Retinal fundus photograph — 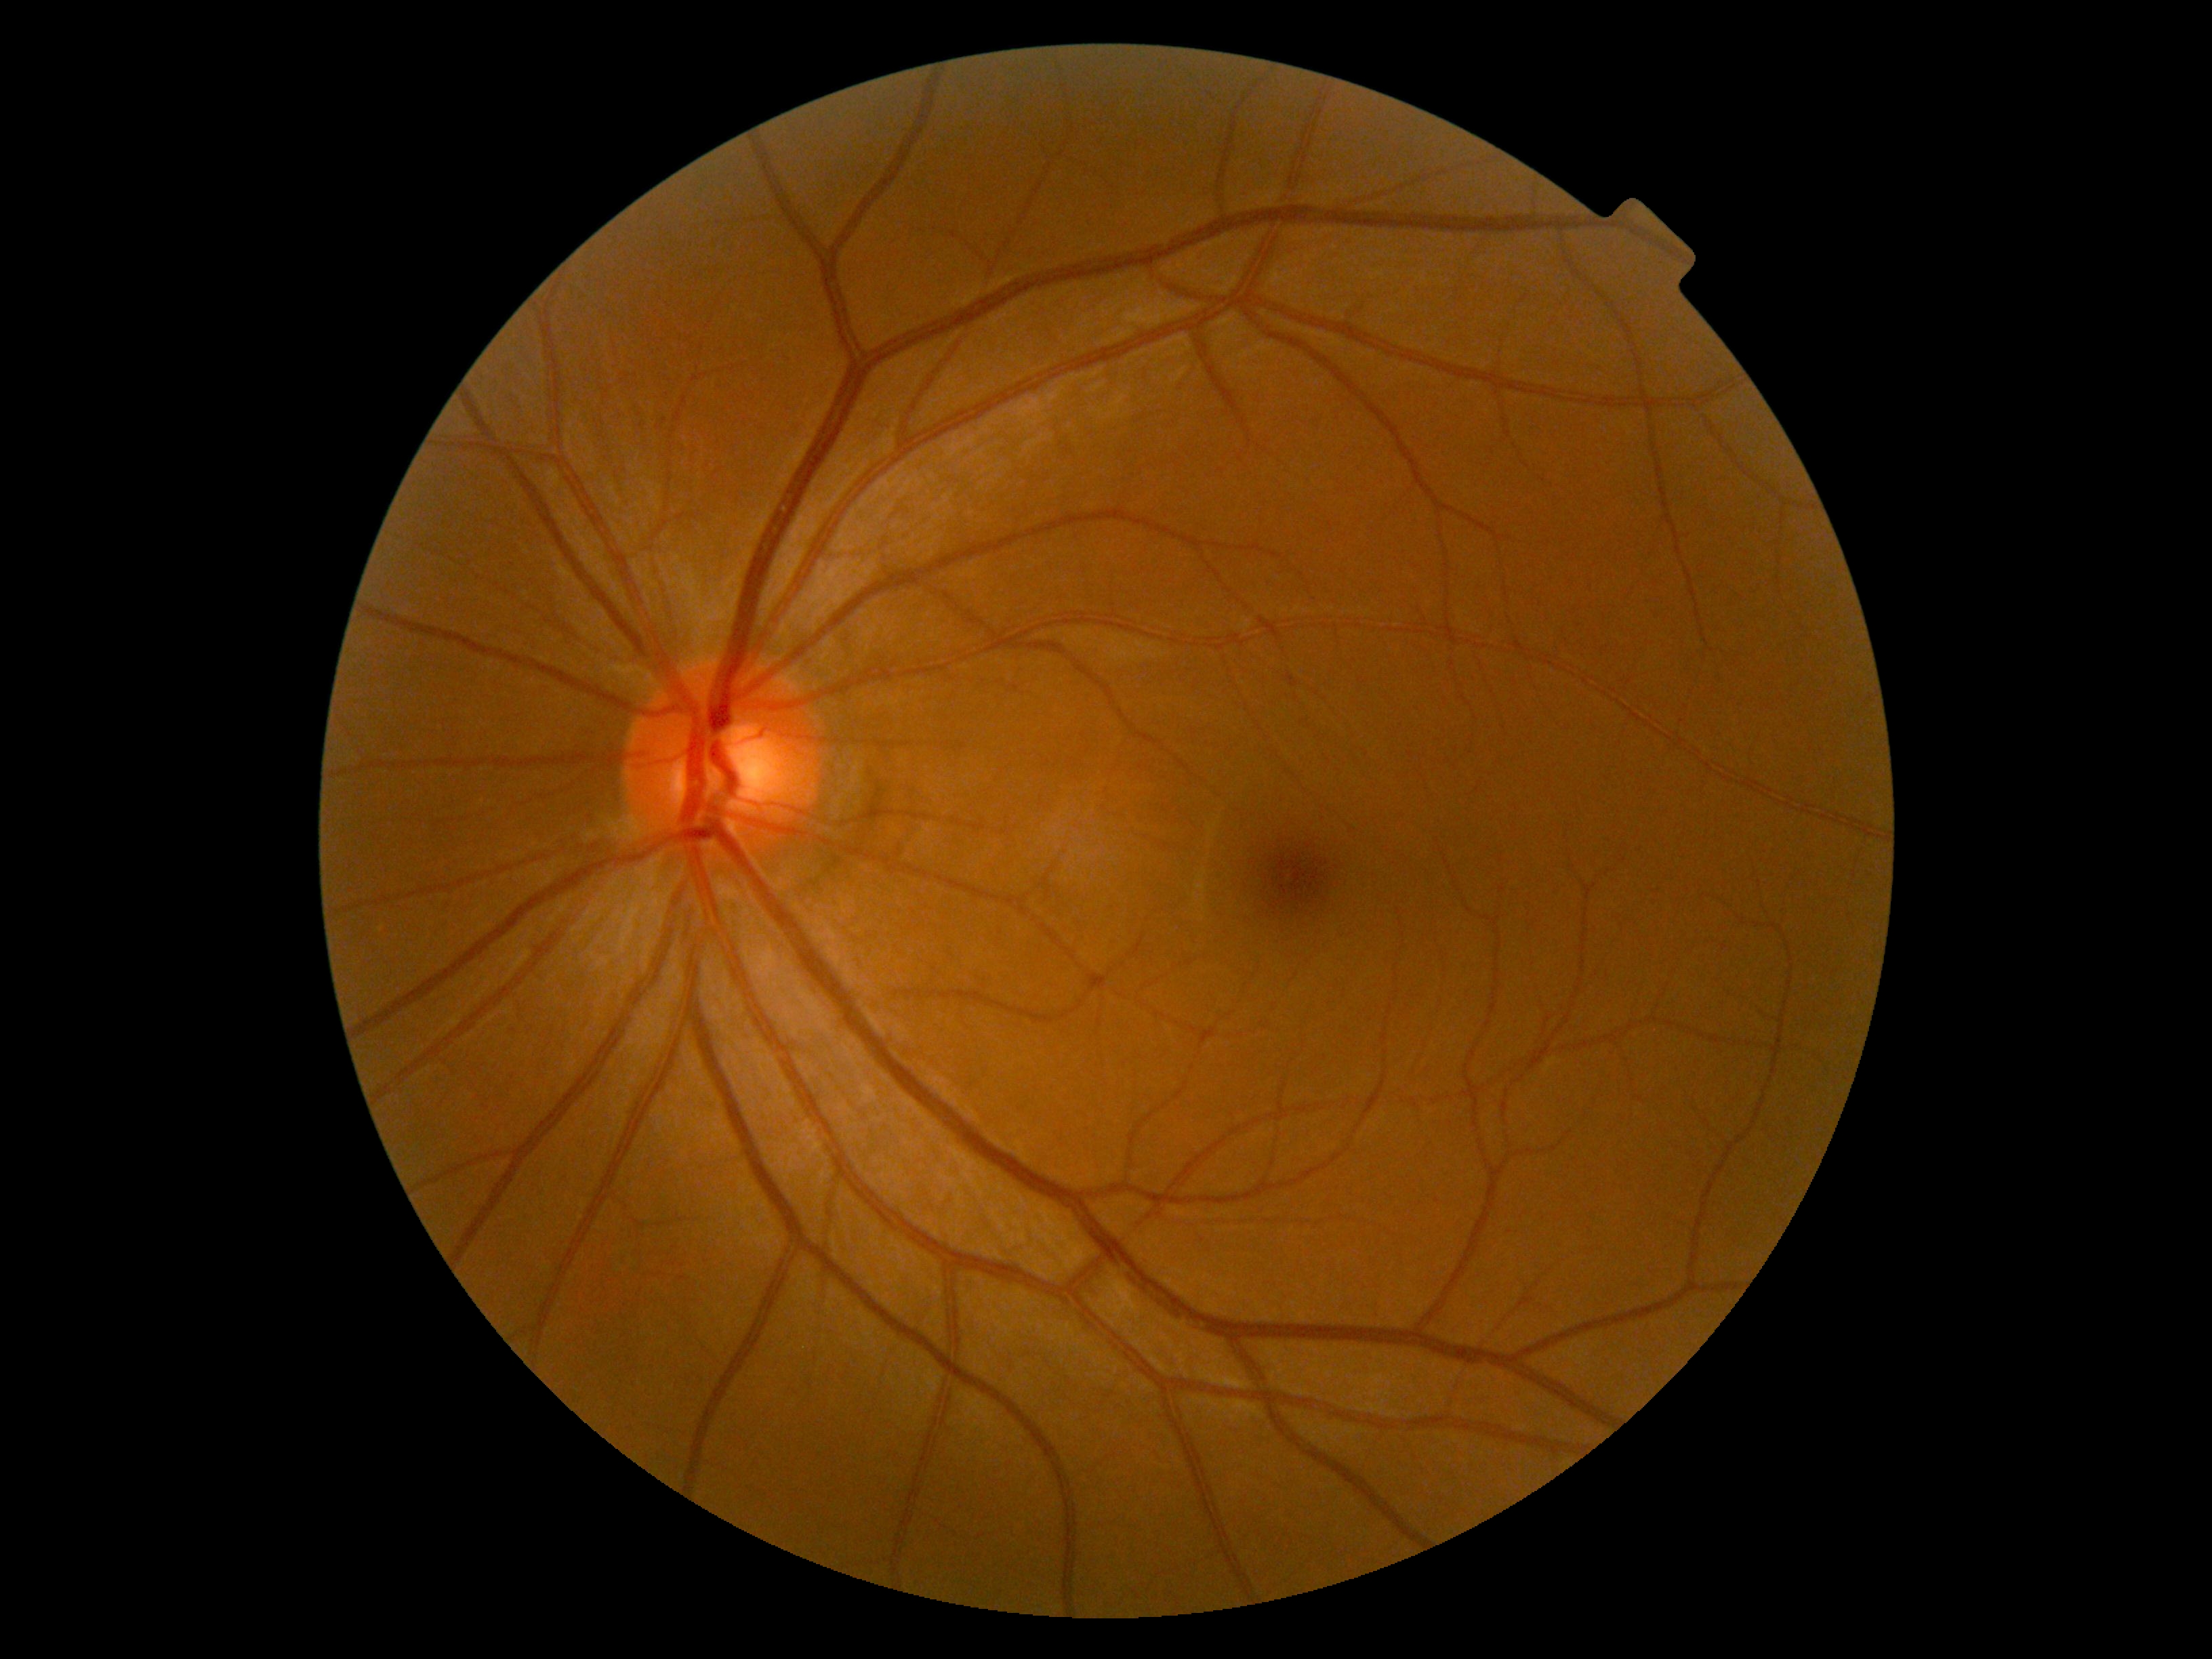
dr_grade: grade 0
dr_impression: no DR findings